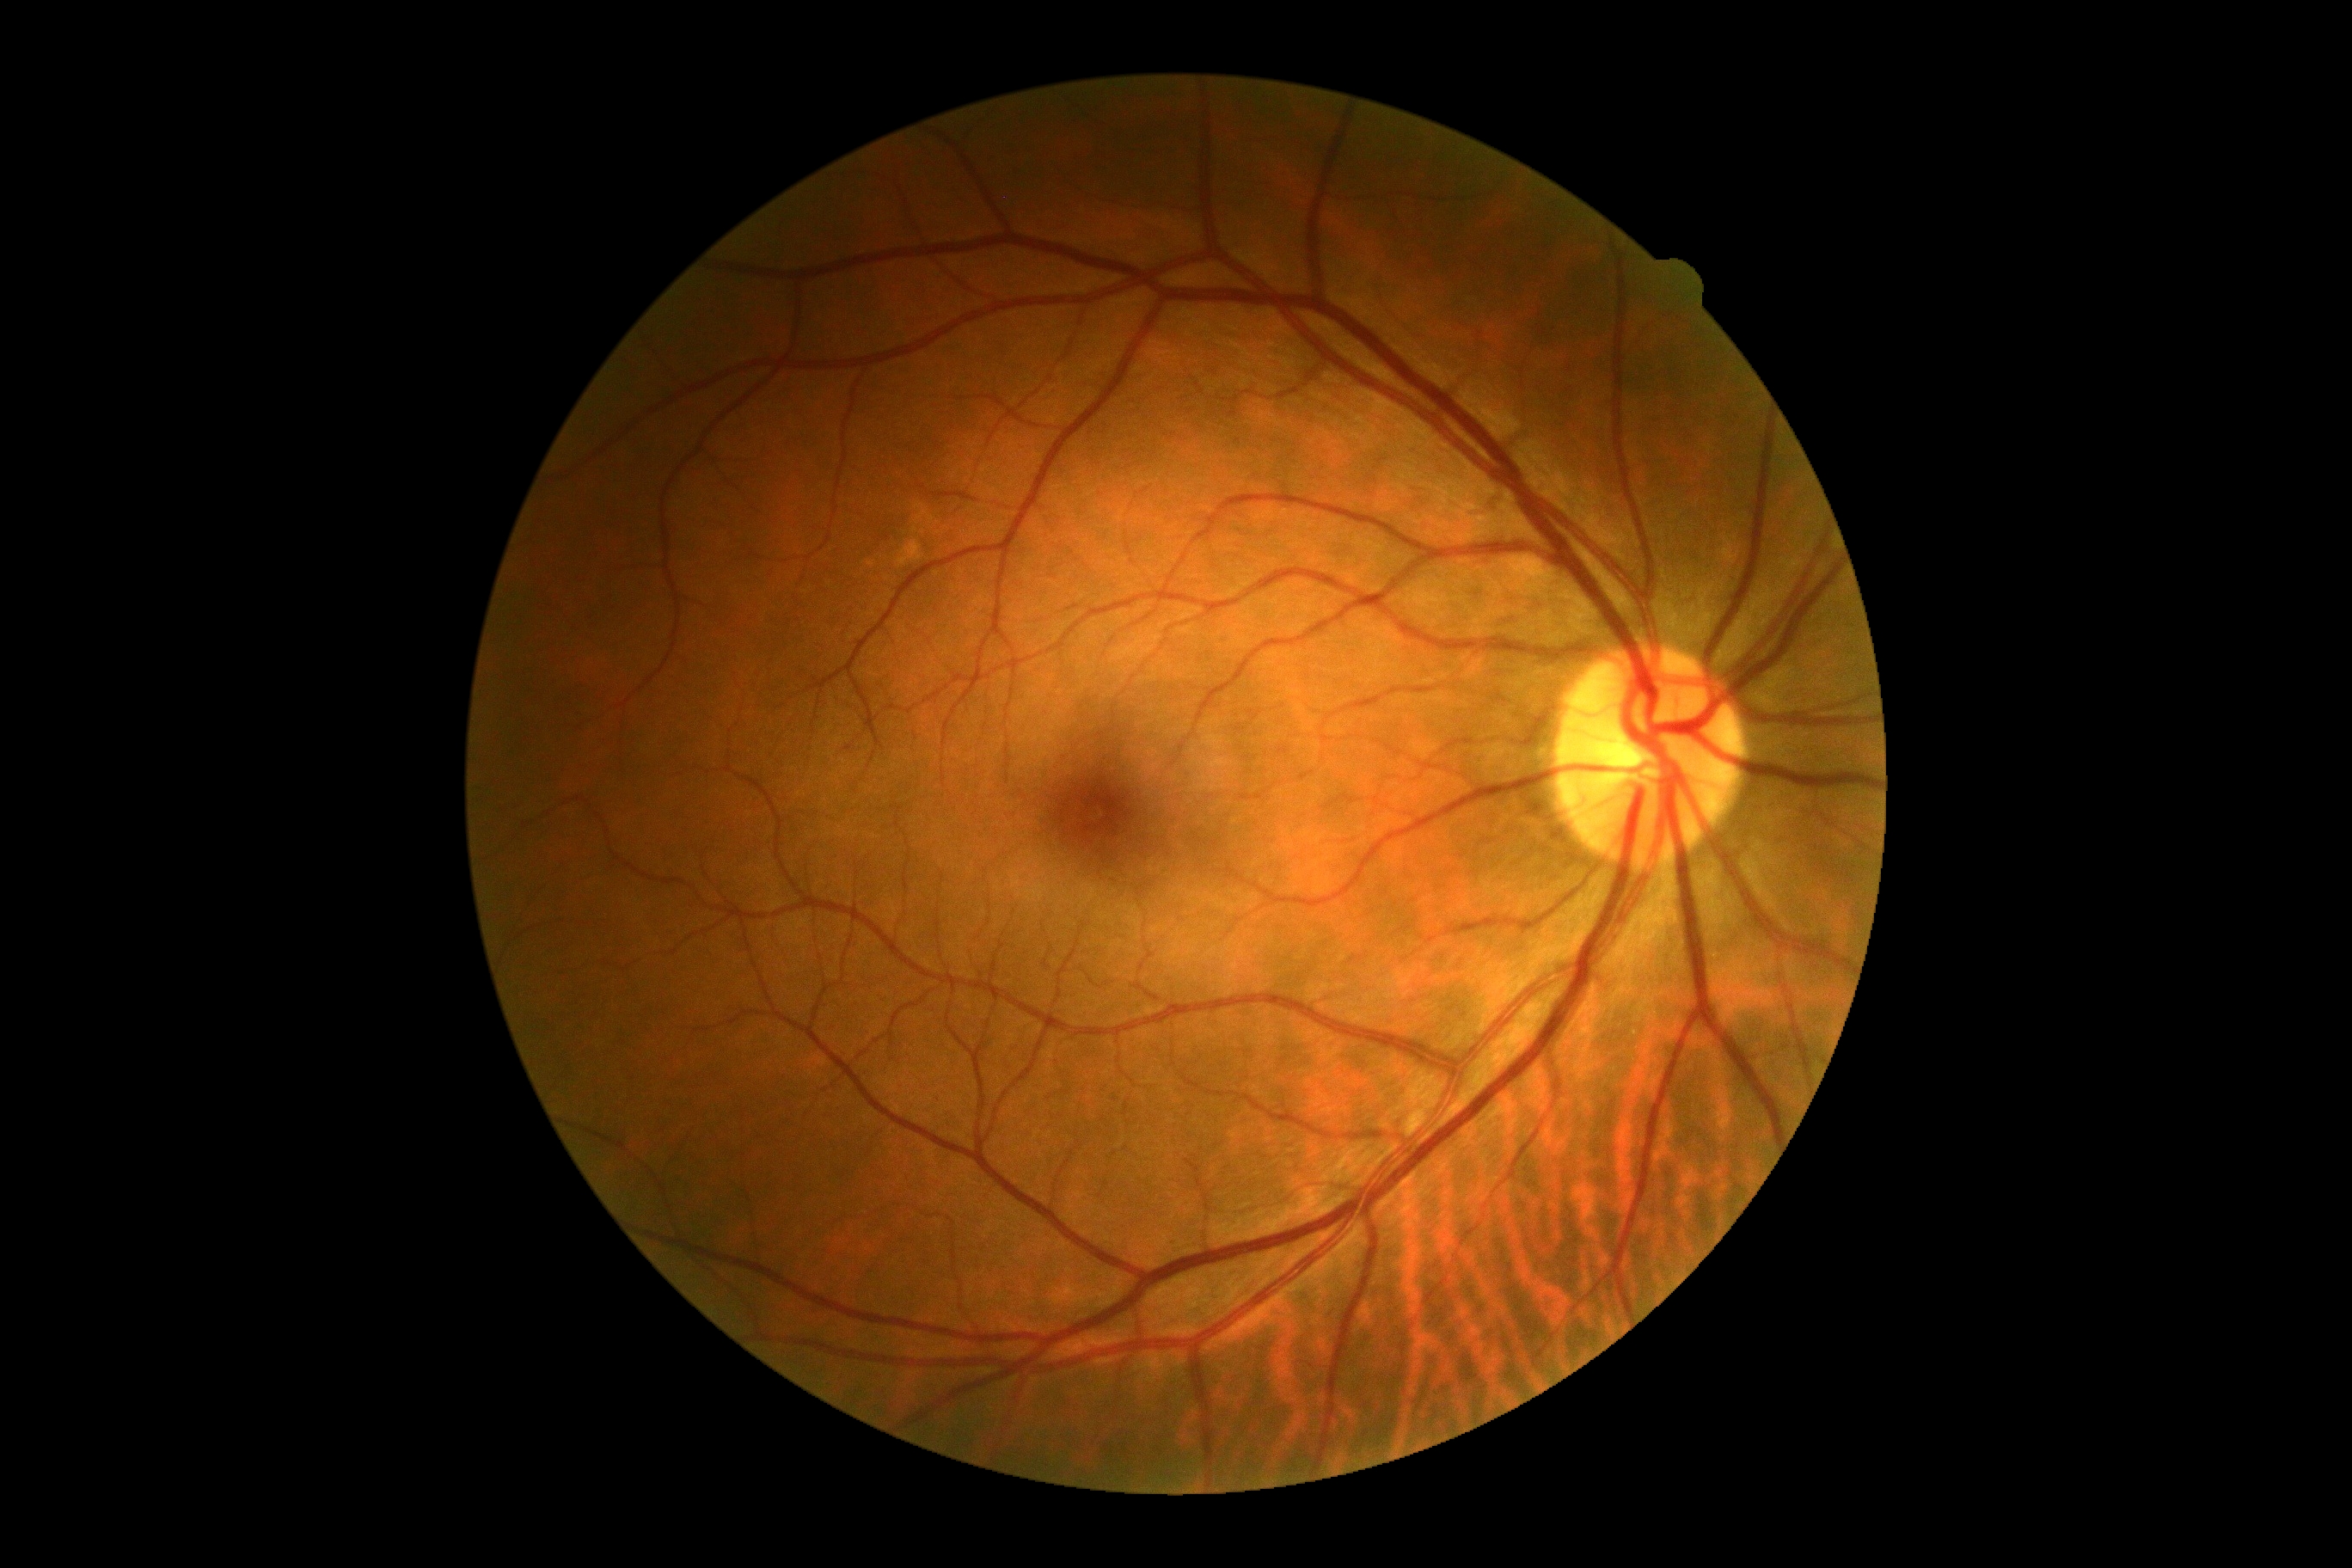
Diabetic retinopathy (DR) is grade 0 (no apparent retinopathy).